Modified Davis grading — 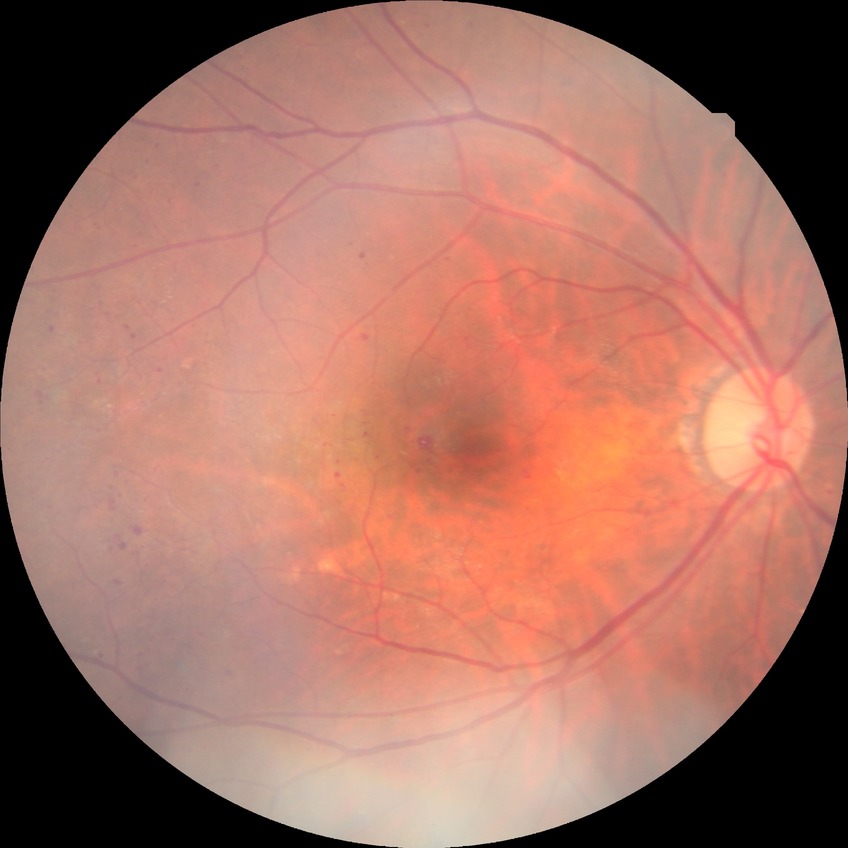

The retinopathy is classified as non-proliferative diabetic retinopathy.
Retinopathy grade is pre-proliferative diabetic retinopathy.